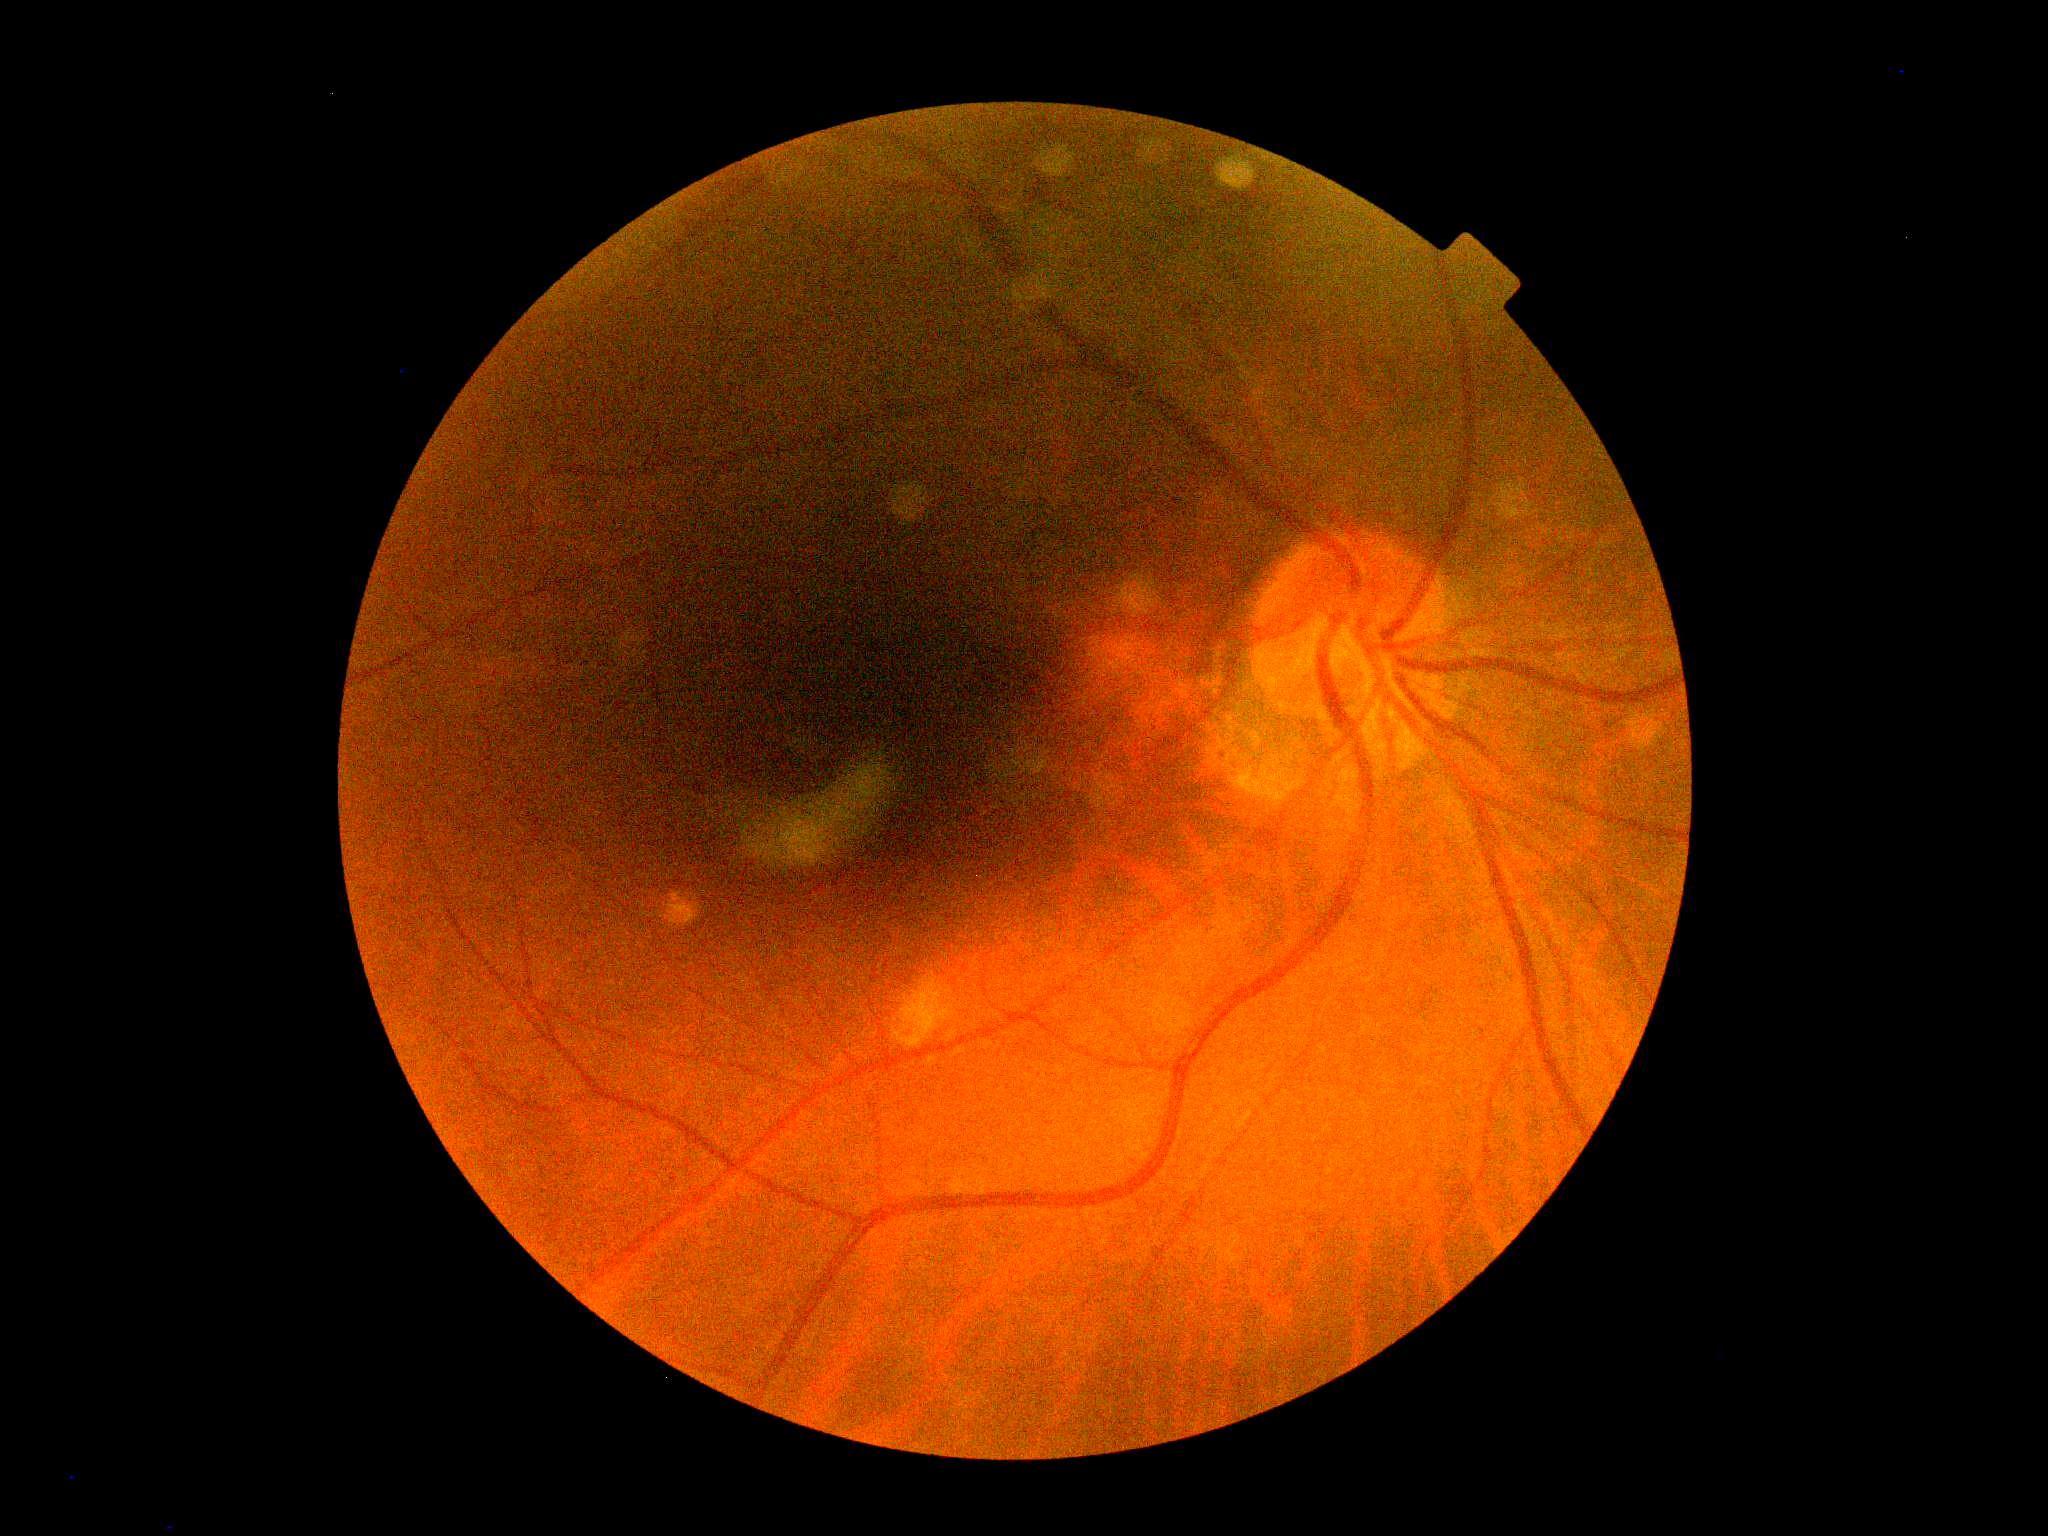
DR severity is no apparent retinopathy (grade 0).